Cropped to the optic nerve head:
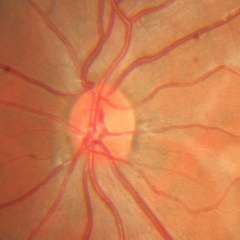 Glaucoma diagnosis: no evidence of glaucoma.